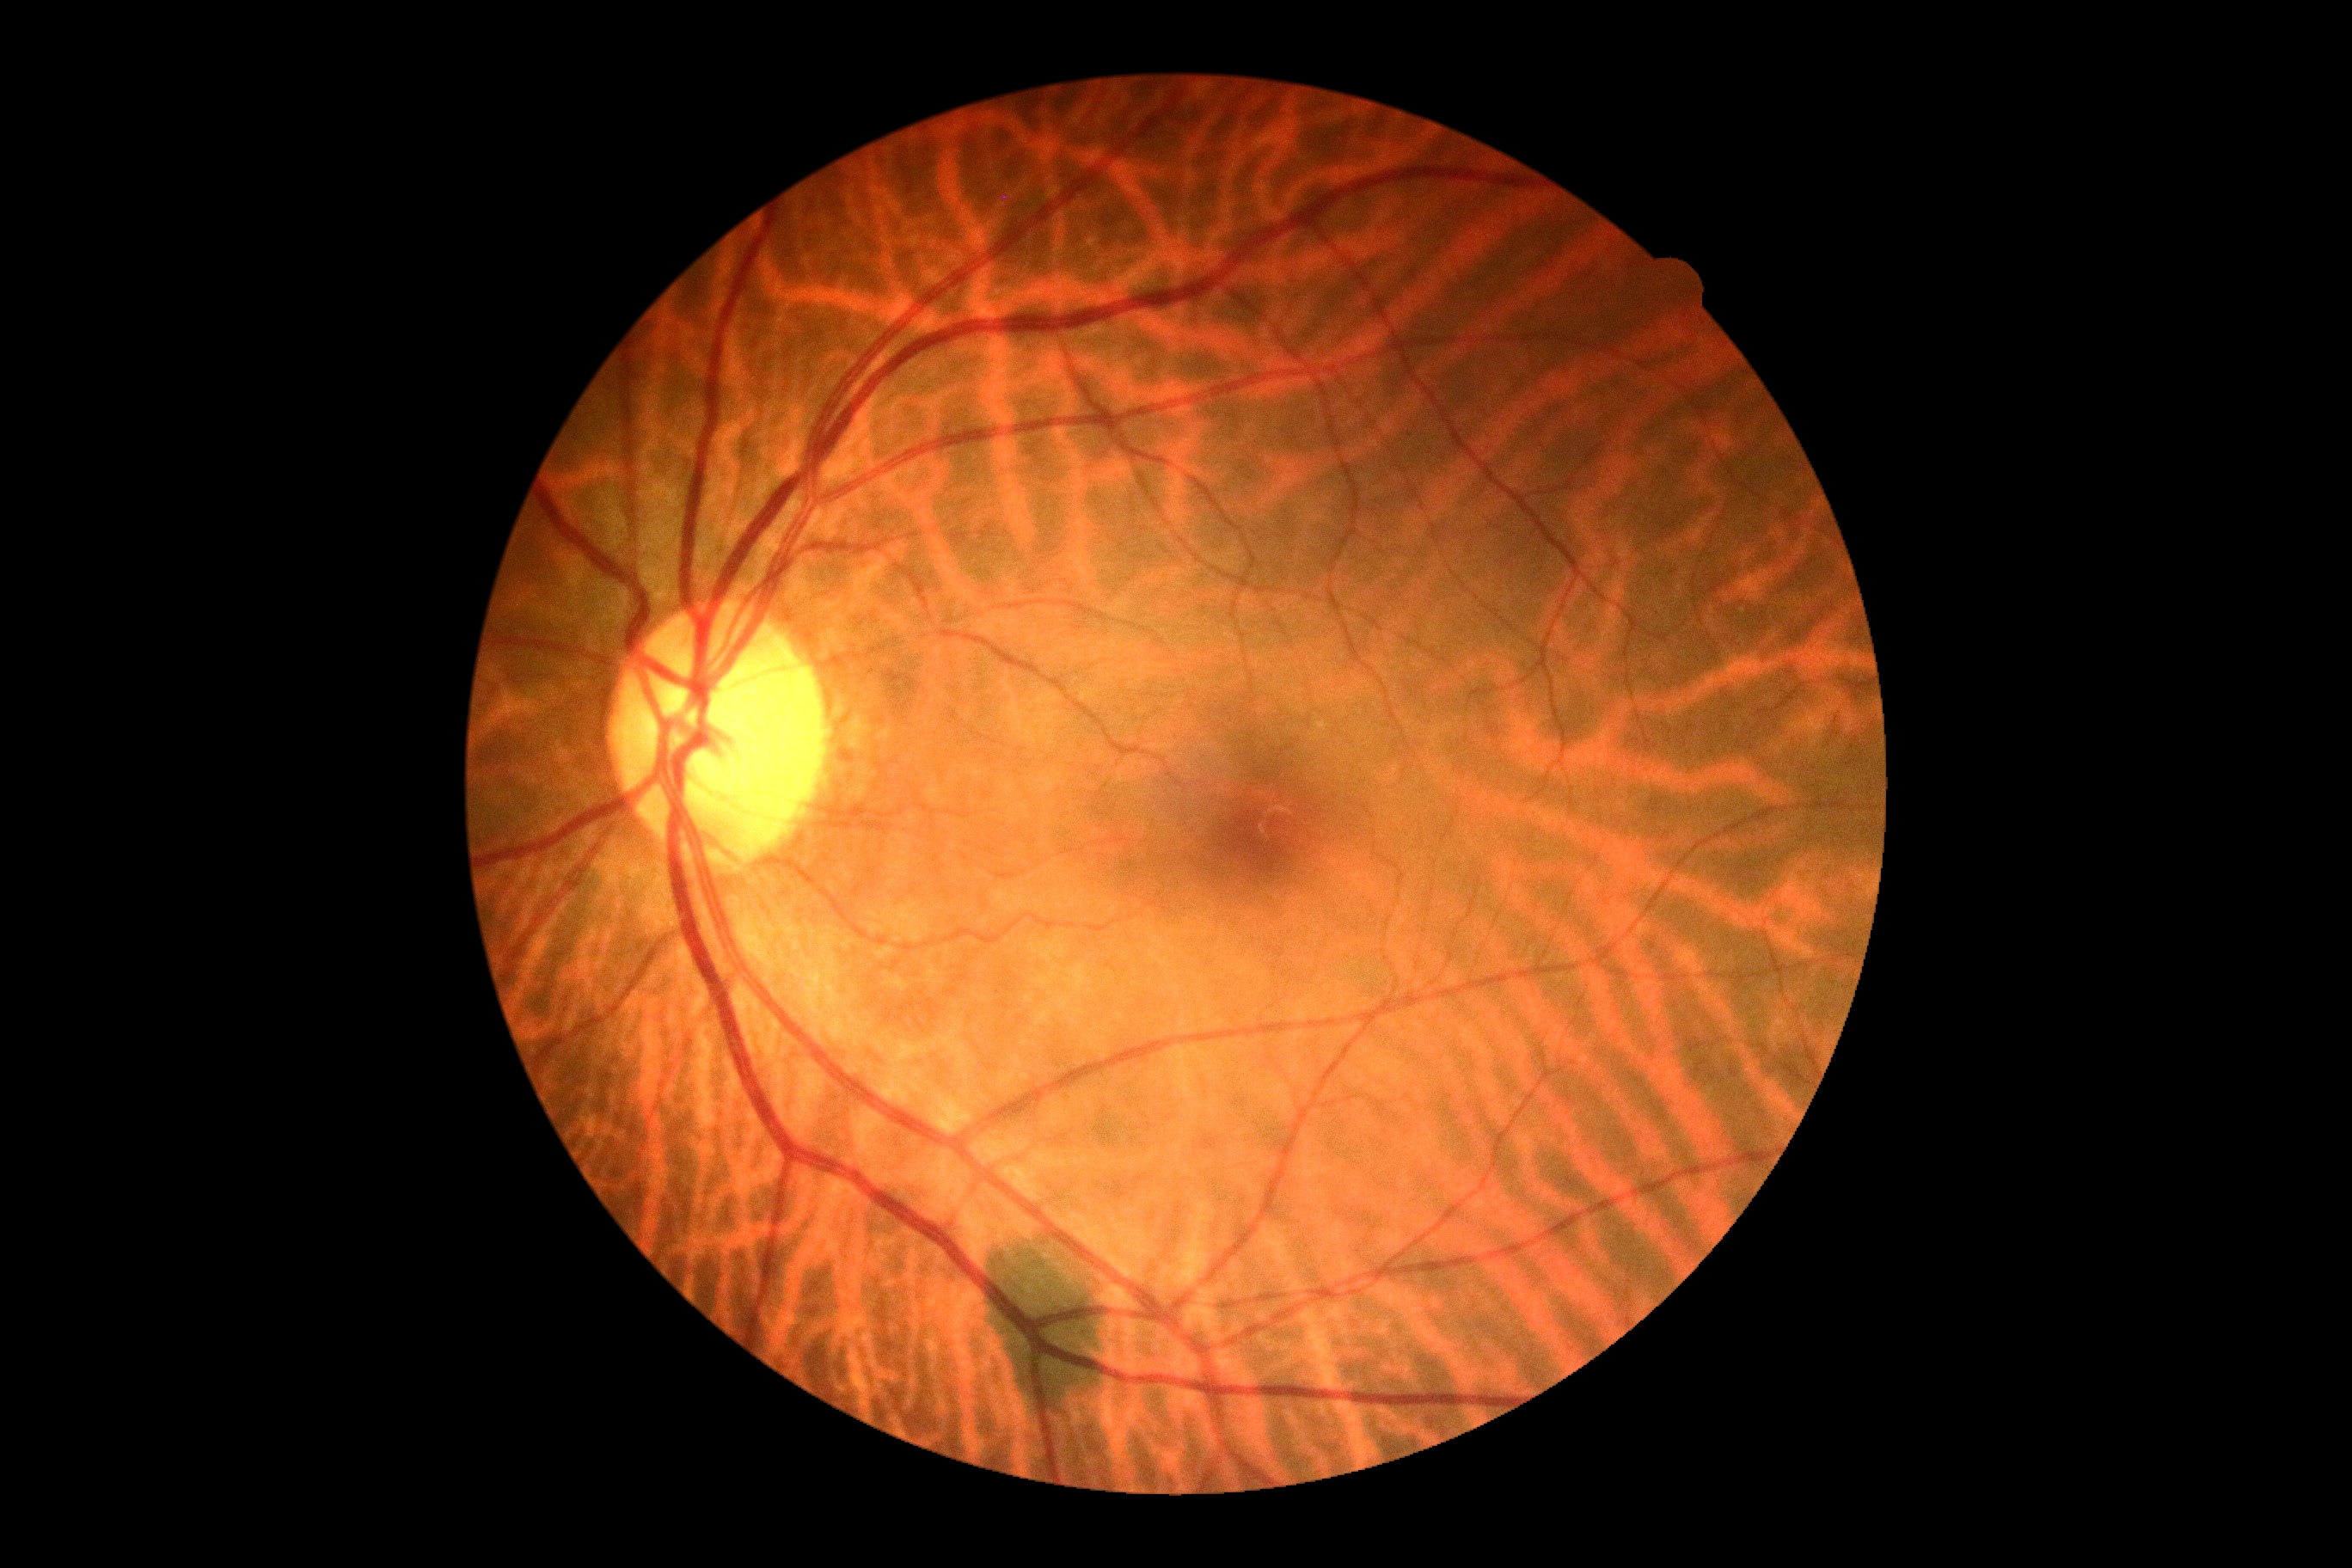

DR stage: no apparent retinopathy (grade 0).
No signs of diabetic retinopathy.